Diabetic retinopathy graded by the modified Davis classification; image size 848x848
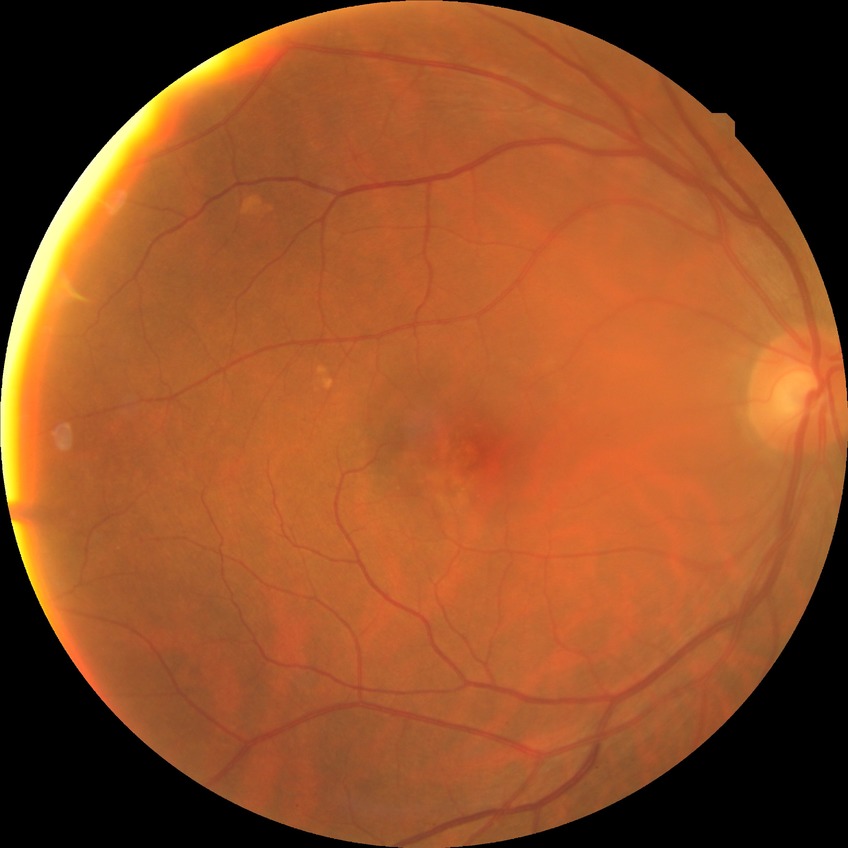
• DR grade: NDR